1240x1240px · wide-field fundus image from infant ROP screening · 100° field of view (Phoenix ICON):
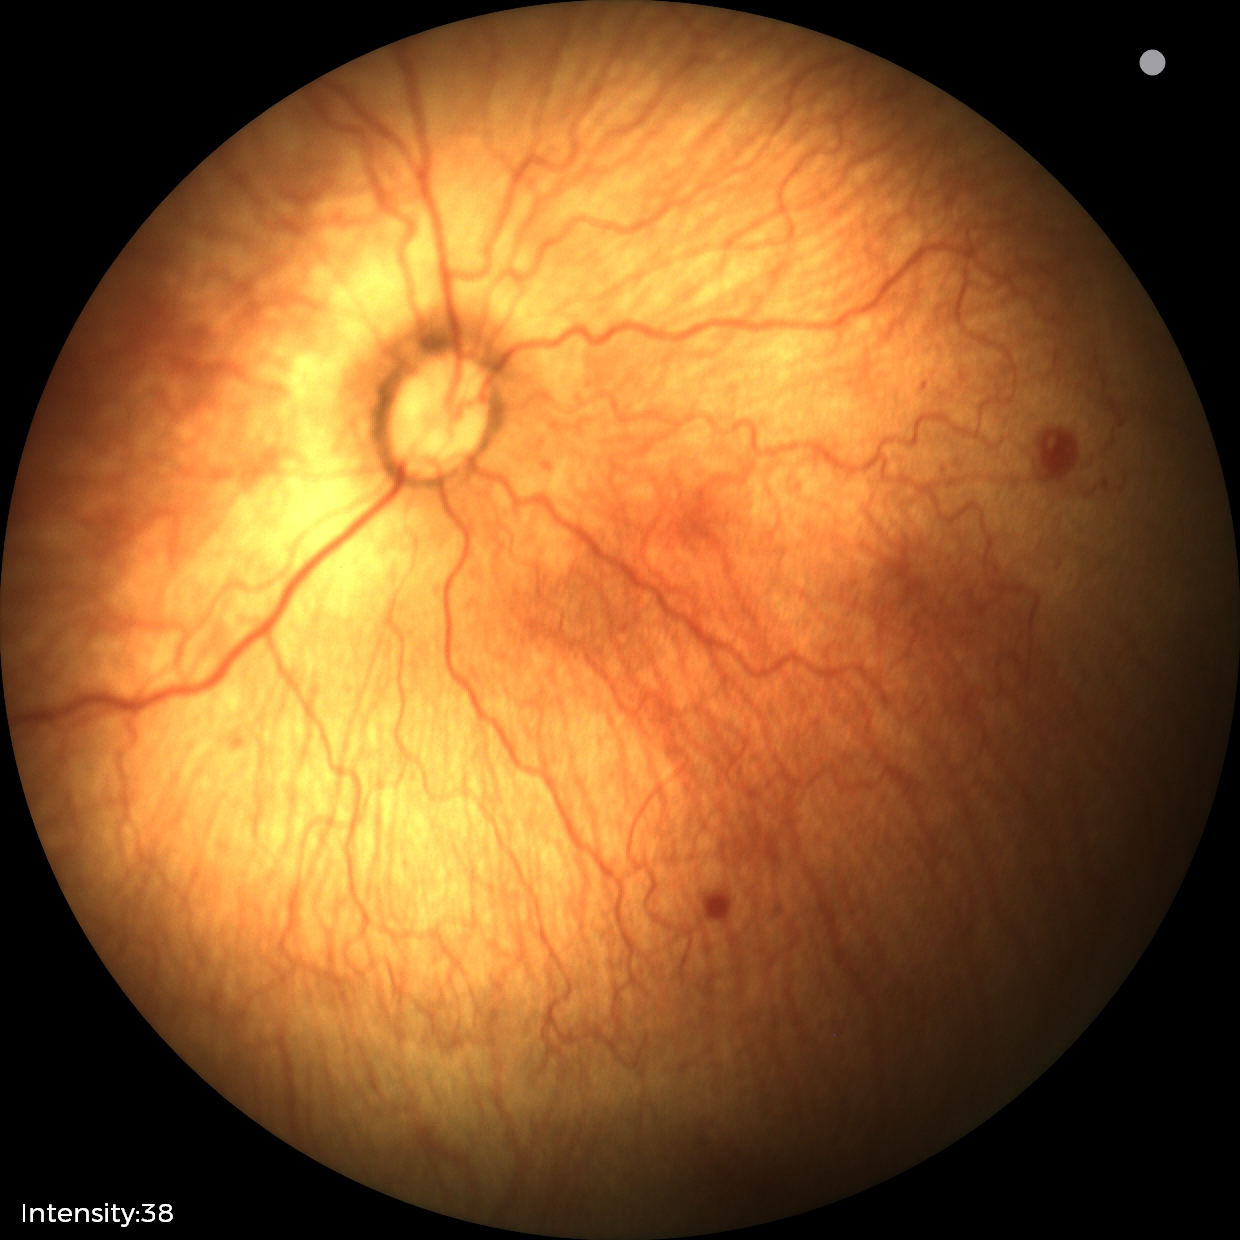 Without plus disease. From an examination with diagnosis of retinopathy of prematurity stage 1.